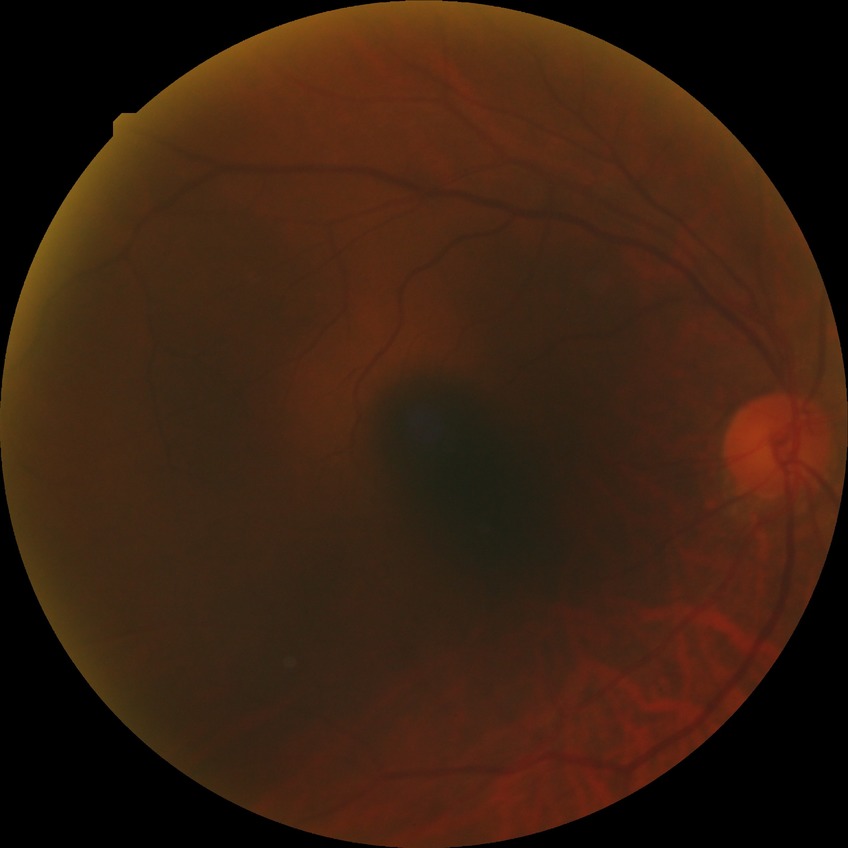 diabetic retinopathy (DR): no diabetic retinopathy (NDR).